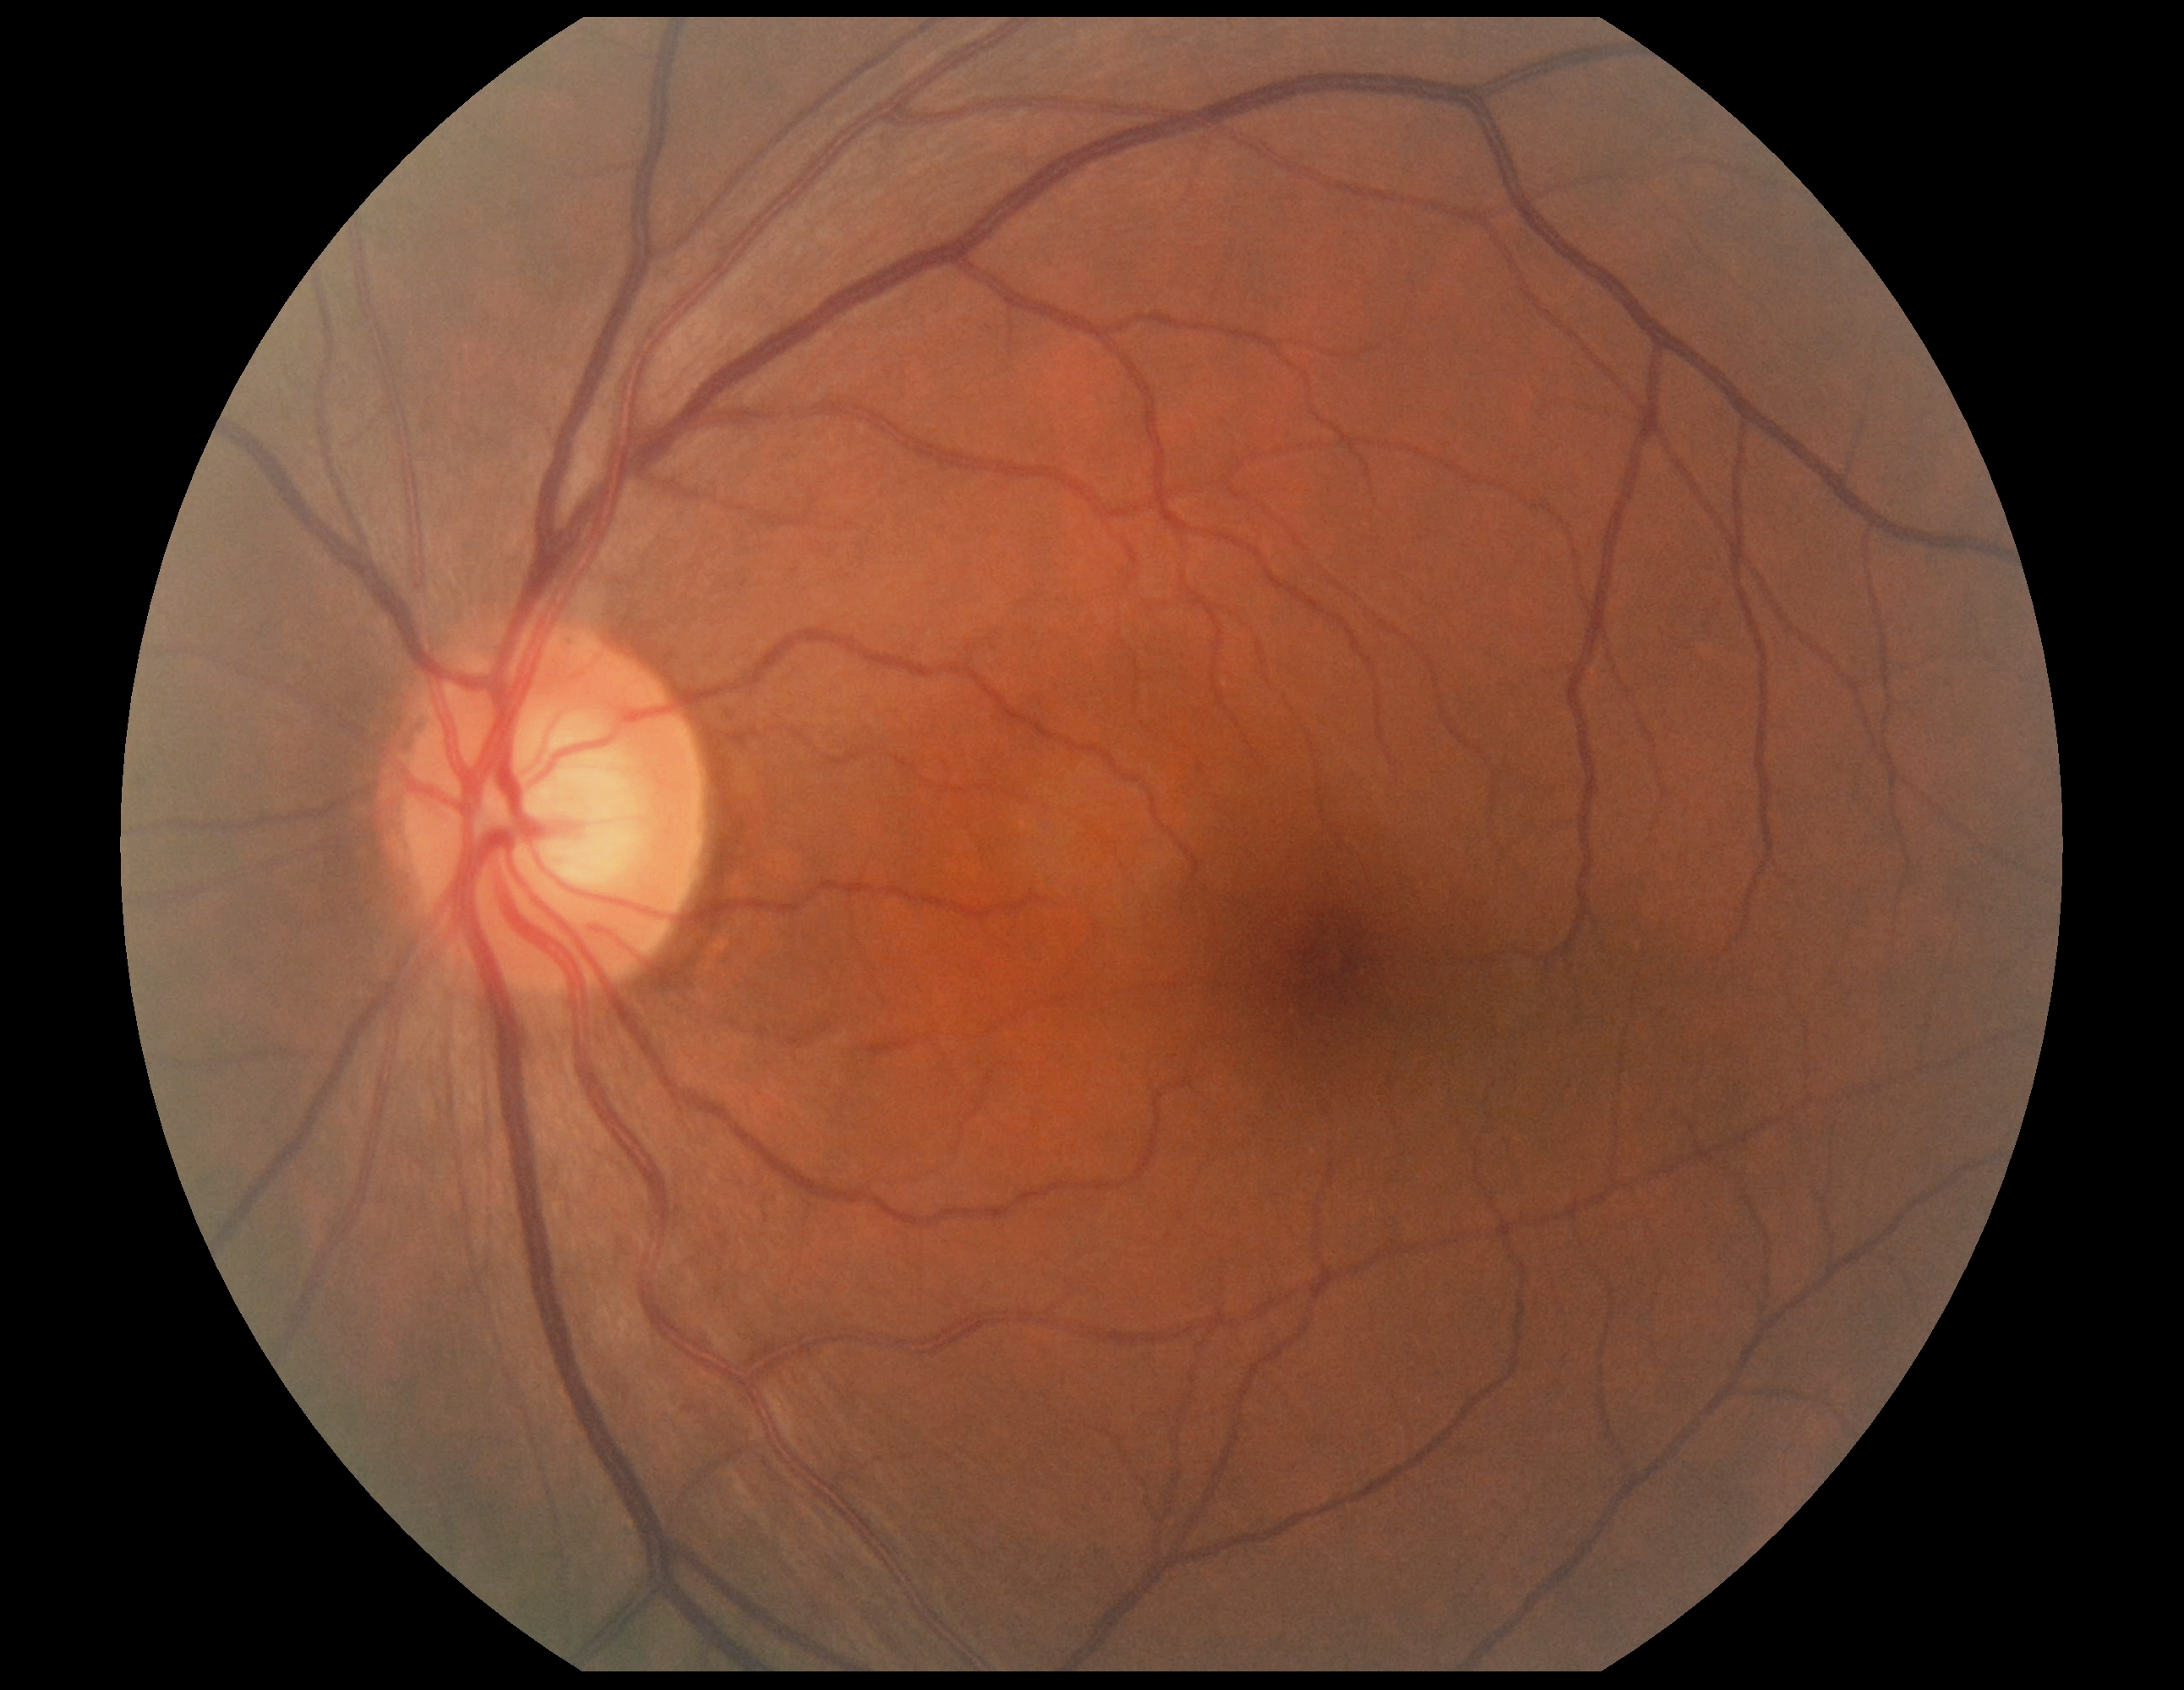 Diabetic retinopathy (DR) is grade 0 (no apparent retinopathy) — no visible signs of diabetic retinopathy.